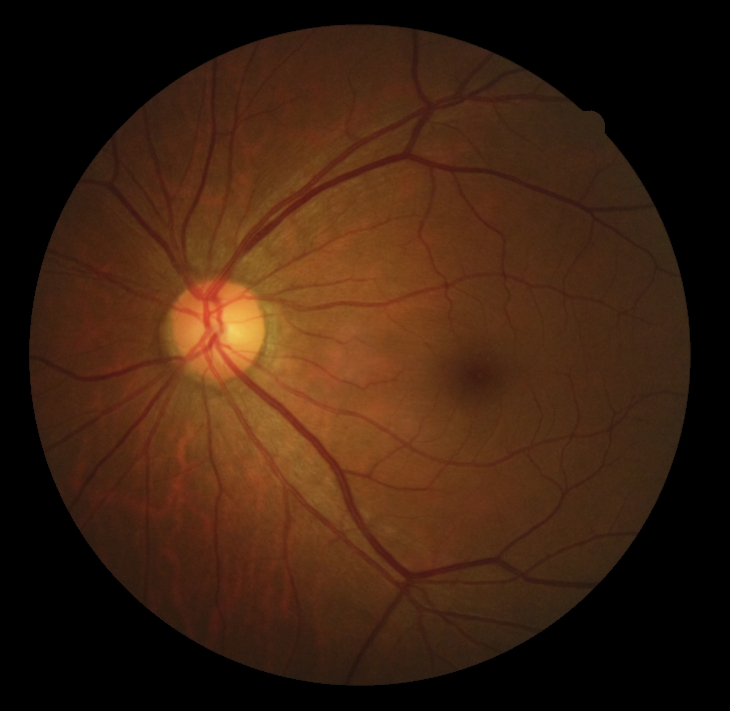

DR severity = no apparent diabetic retinopathy (grade 0), DR impression = negative for DR.